1932 by 1916 pixels; FOV: 45 degrees.
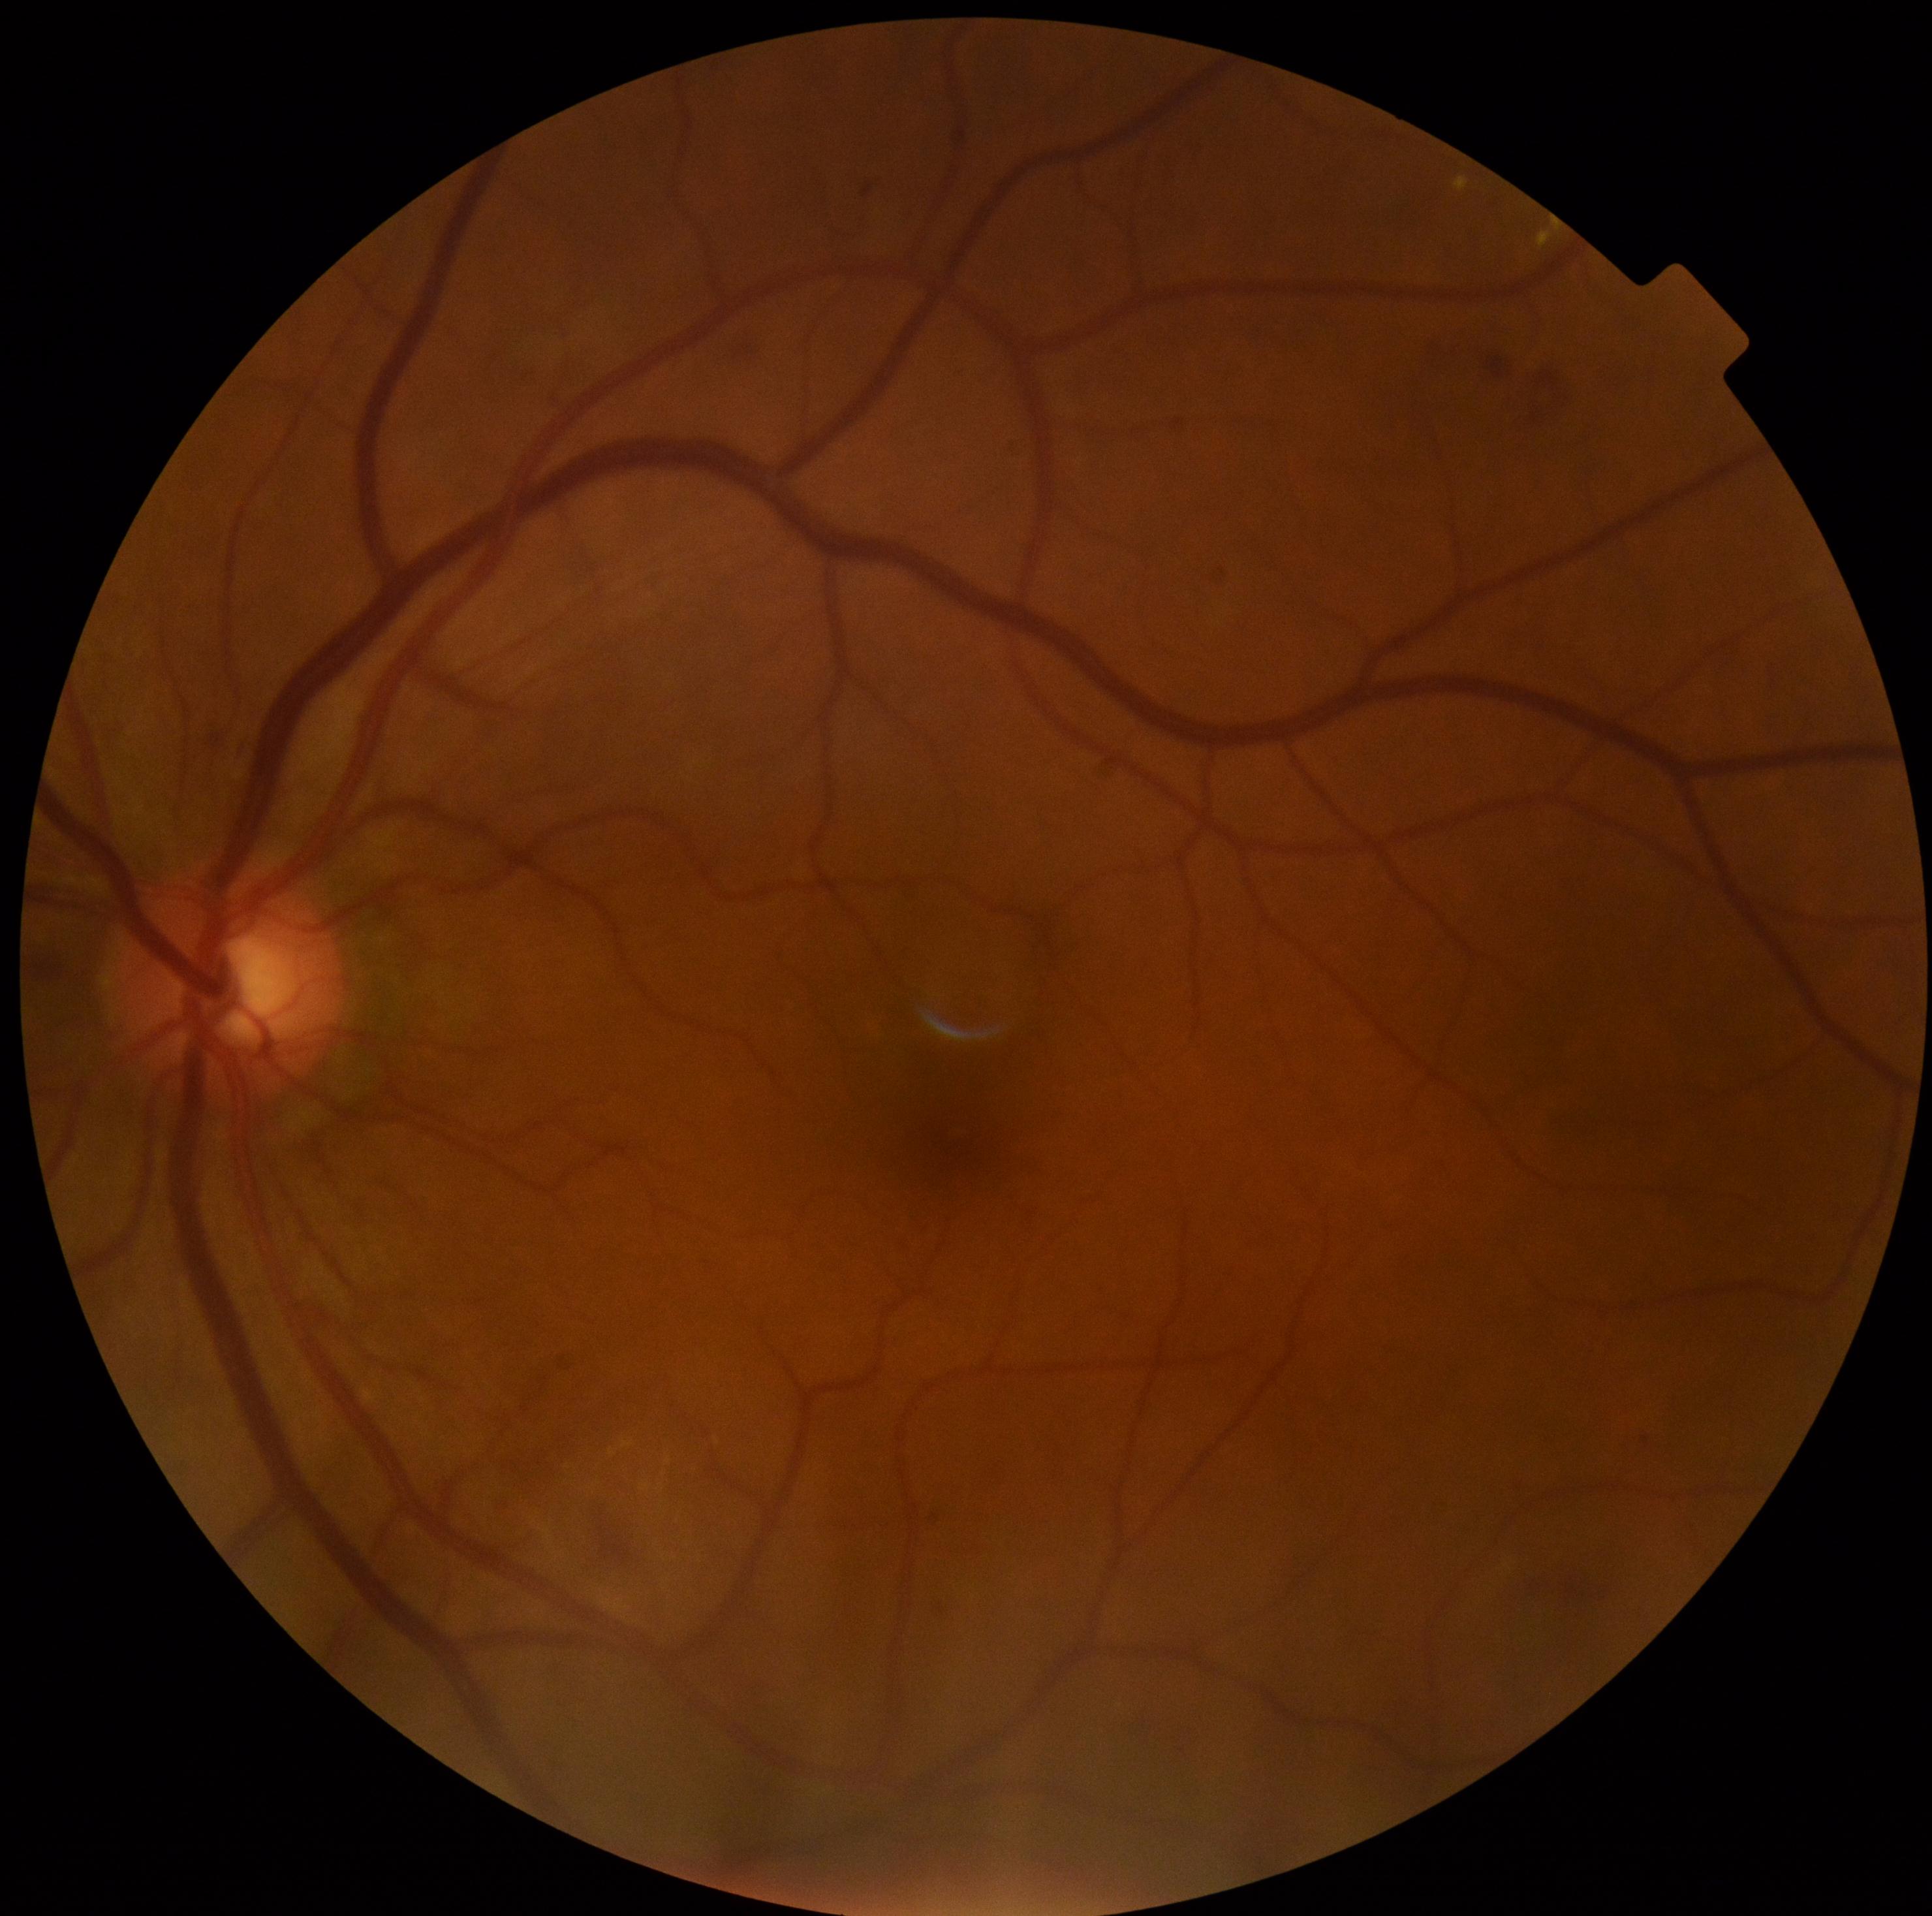

diabetic retinopathy severity: moderate NPDR (grade 2)